Image size 2352x1568, 45° FOV, CFP — 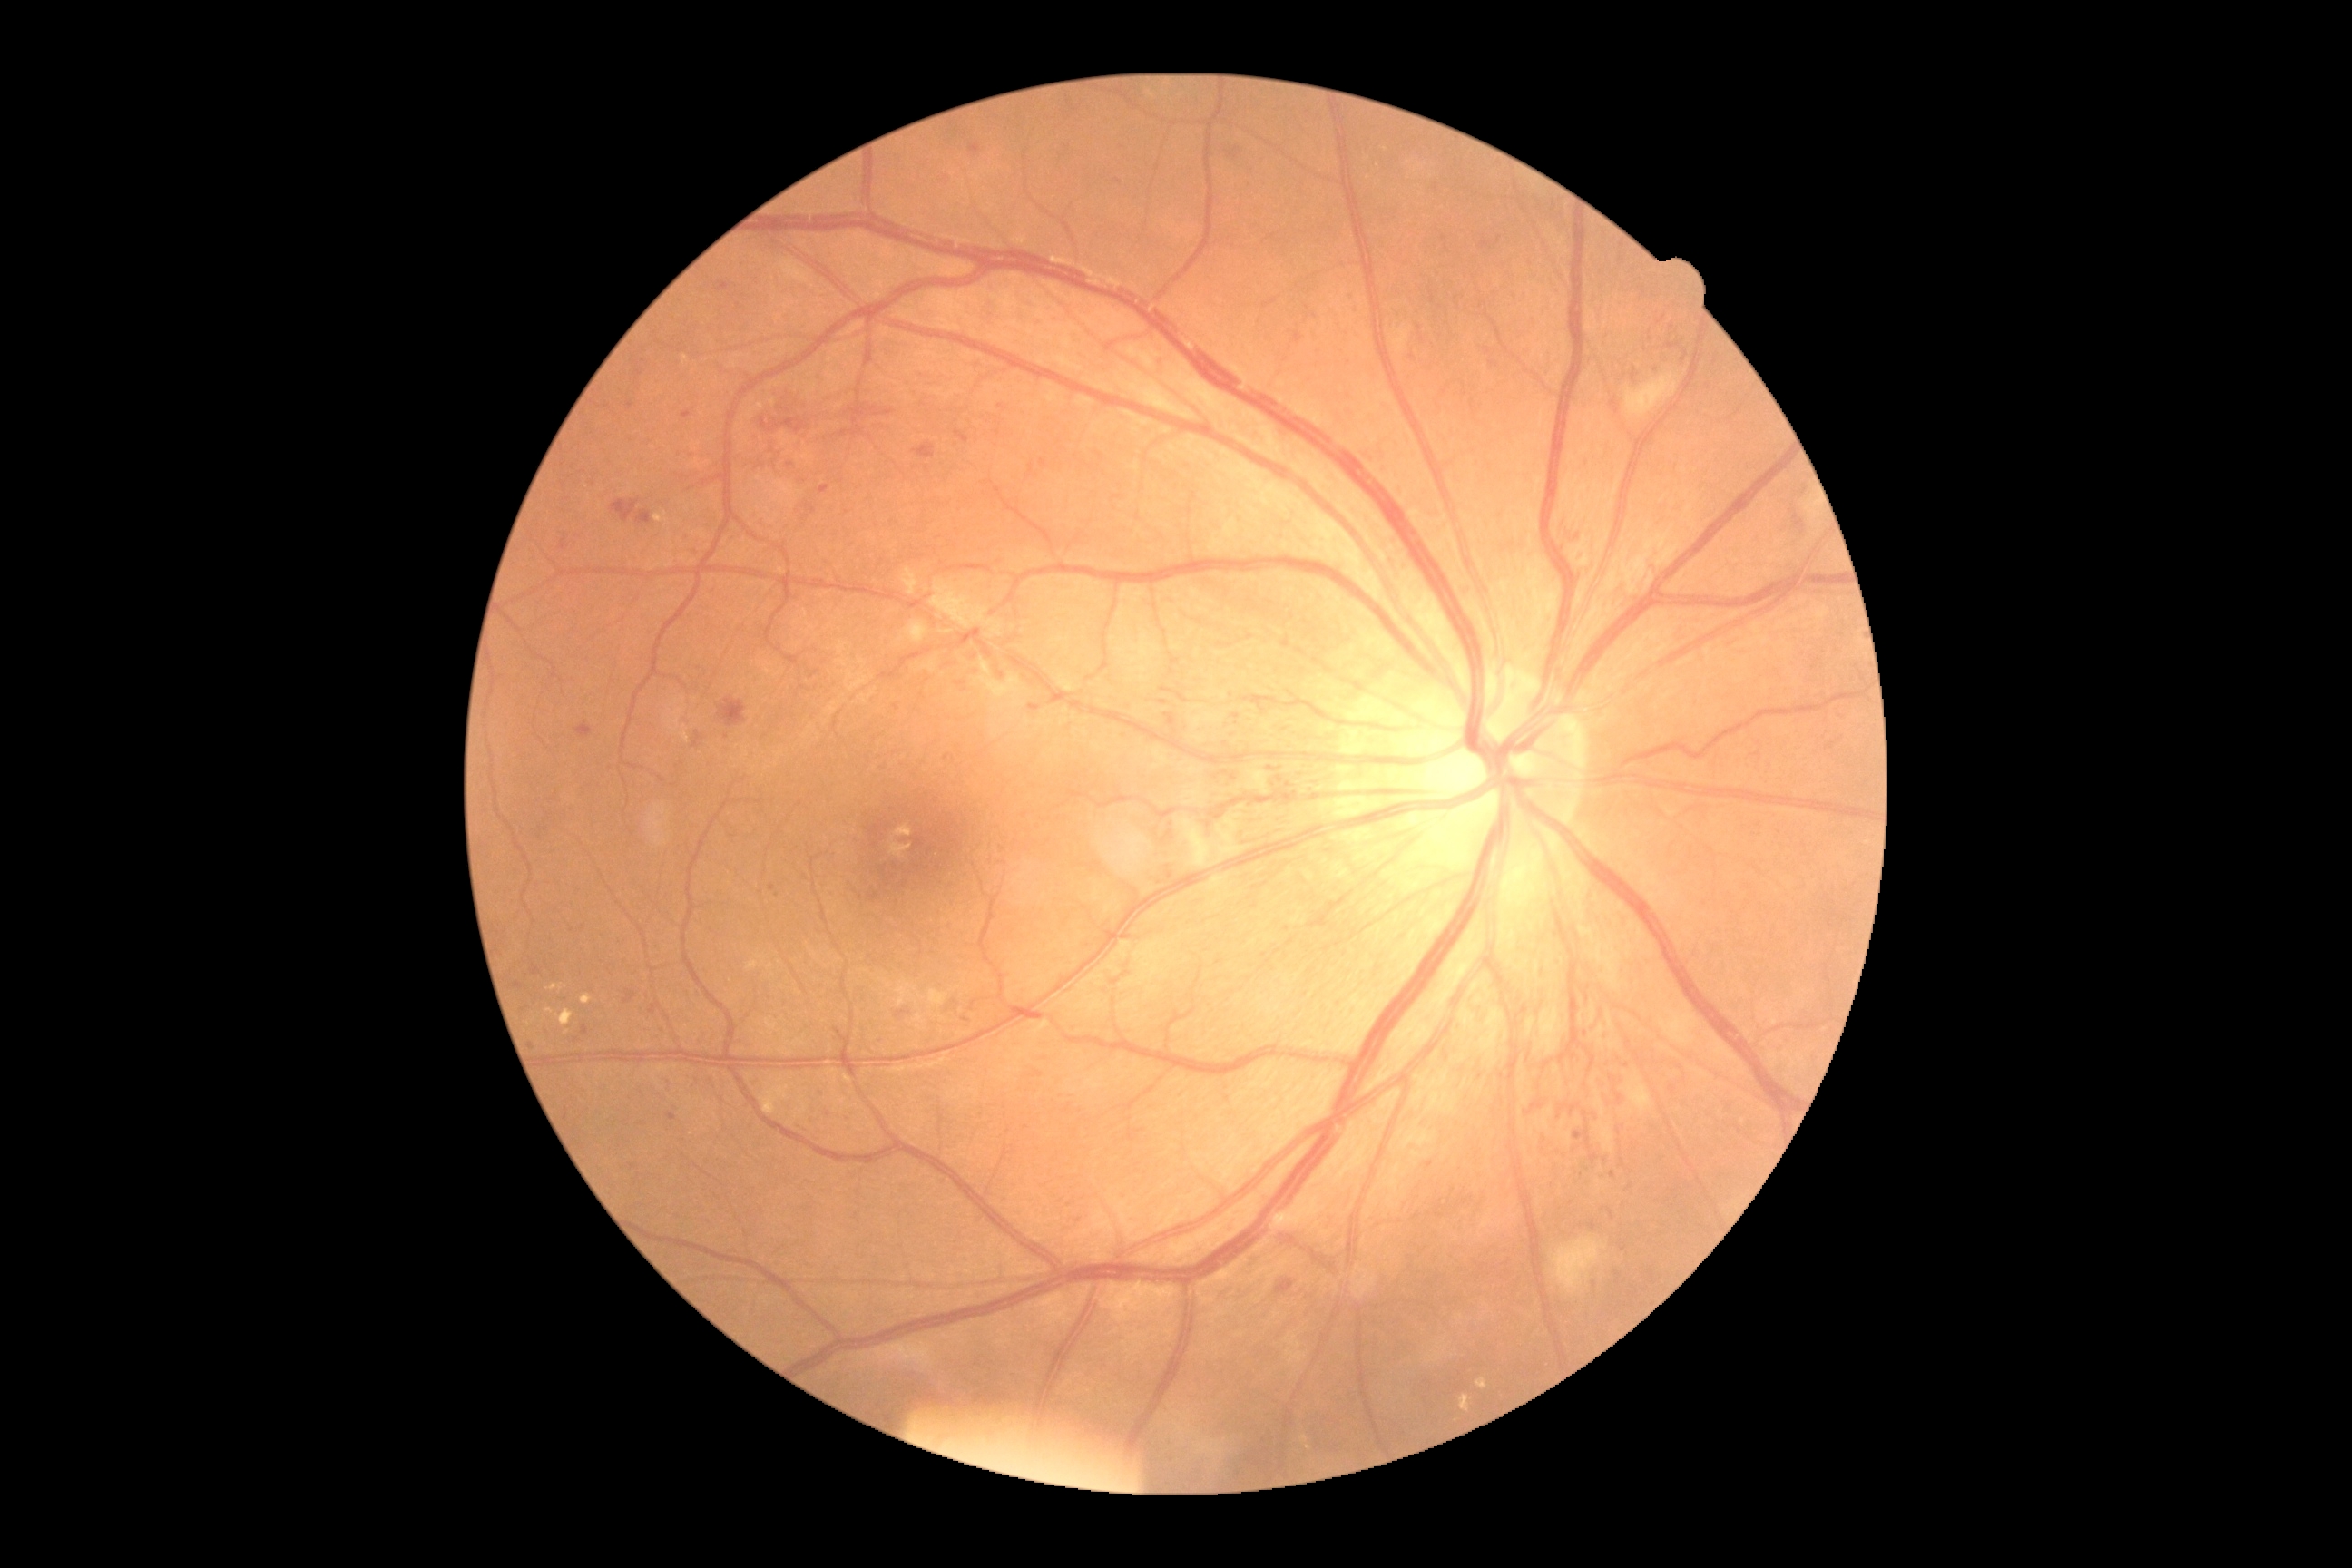
Diabetic retinopathy (DR) is grade 3
Representative lesions:
hemorrhages (HEs) (more not shown): 897:1010:906:1019 | 649:1003:662:1015 | 1269:776:1282:785 | 956:431:970:444 | 636:511:652:525 | 611:500:640:524 | 1667:344:1678:349 | 870:406:896:418 | 1652:364:1660:369 | 1683:353:1689:362 | 1293:333:1304:344 | 1264:767:1280:770
Additional small HEs near [x=1236, y=717] | [x=1803, y=492]